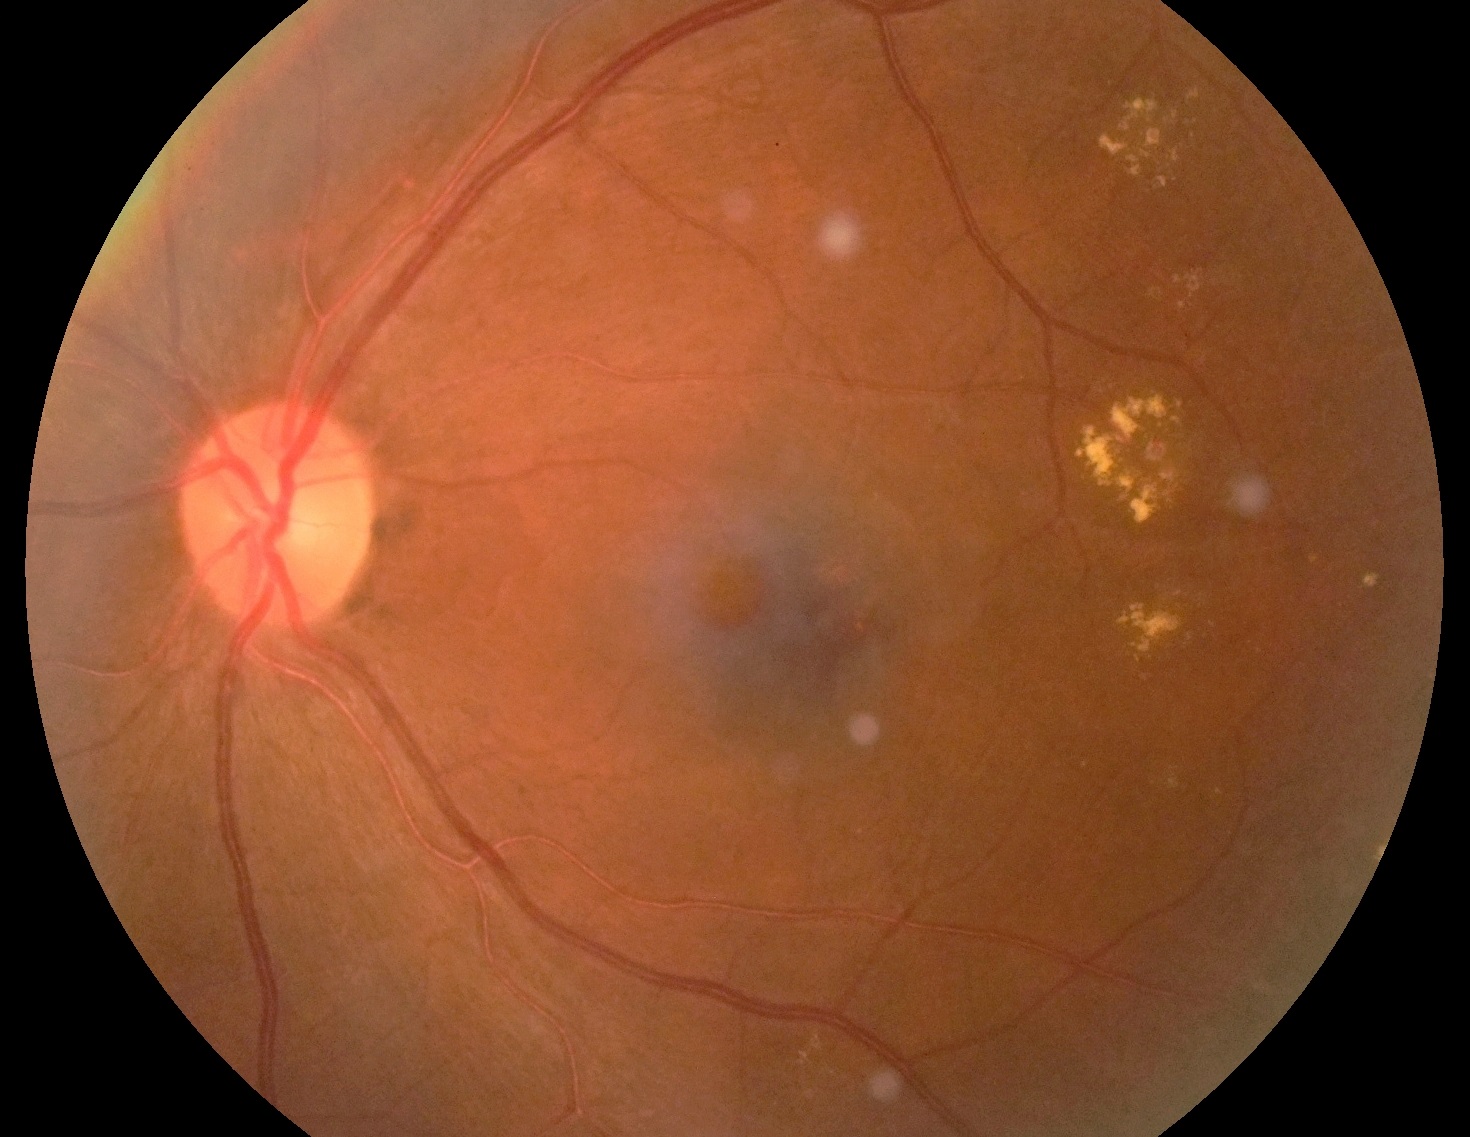 Findings:
– DR — grade 2